Fundus photo.
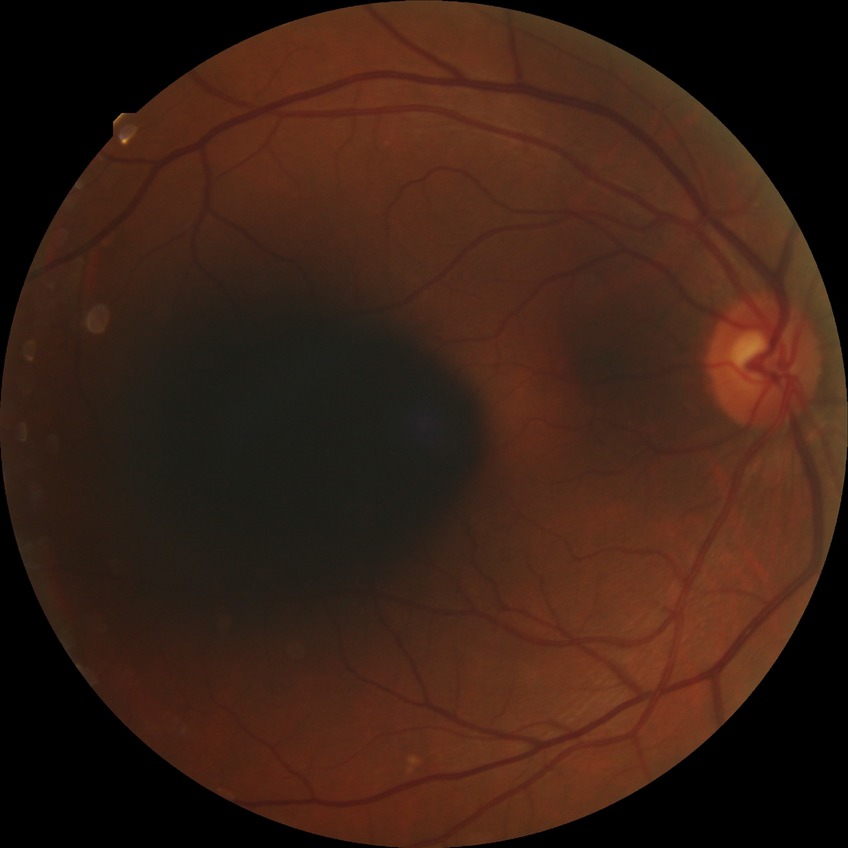 Diabetic retinopathy (DR): no diabetic retinopathy (NDR).